Pediatric retinal photograph (wide-field).
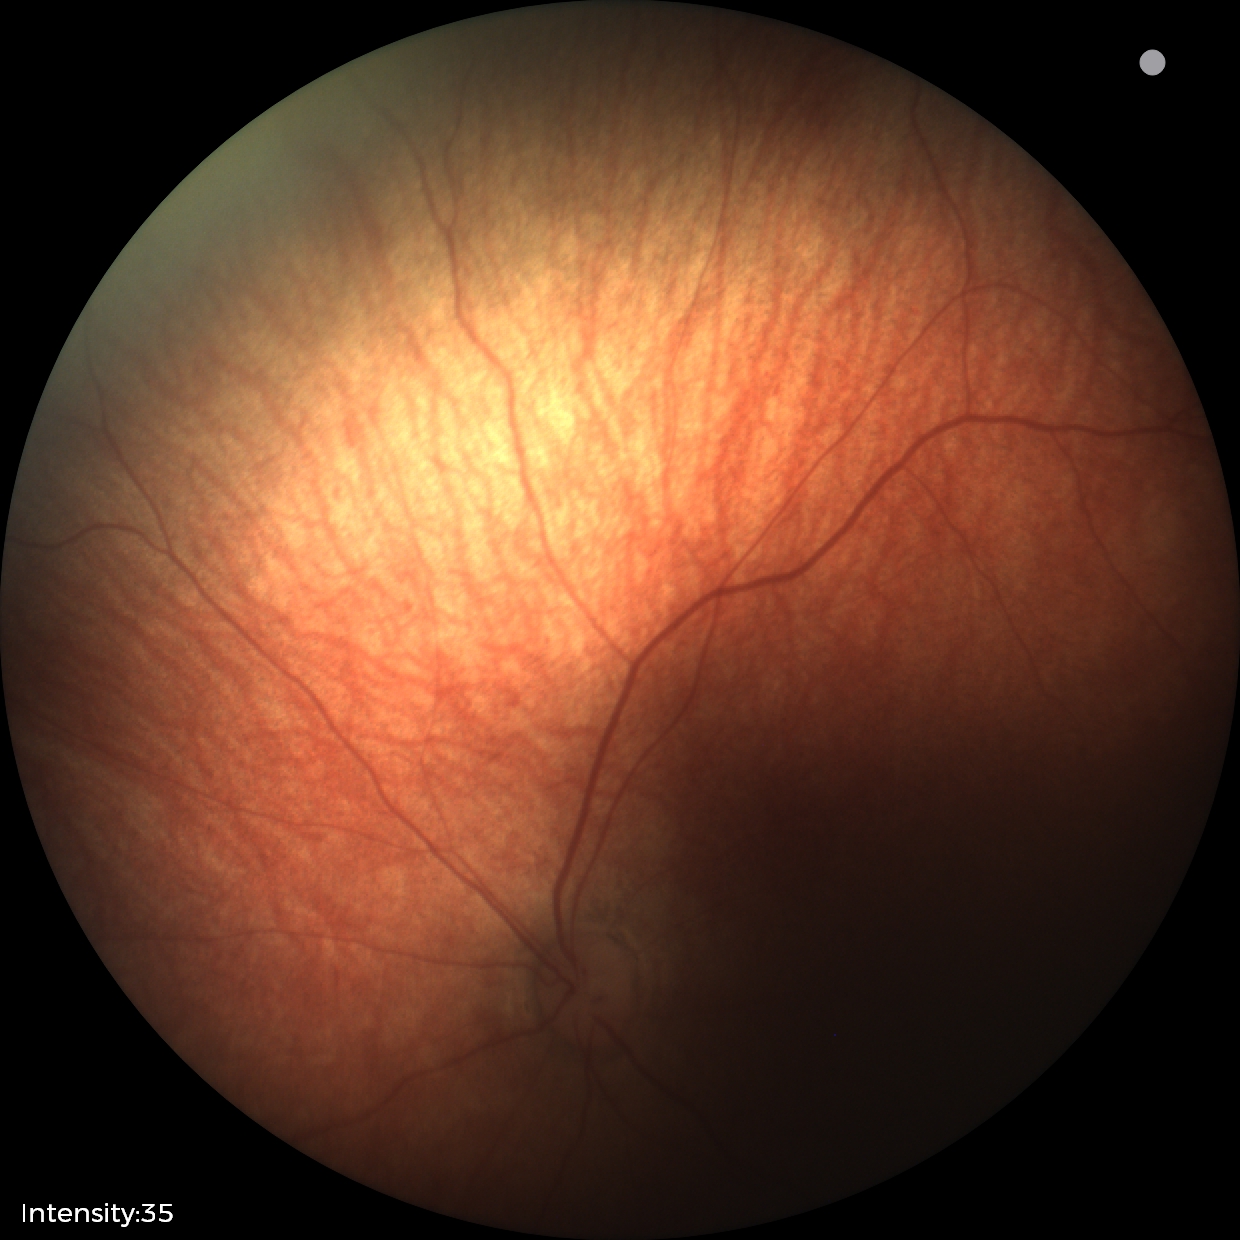

Screening examination diagnosed as physiological.